640 x 480 pixels. Pediatric retinal photograph (wide-field). 130° field of view (Clarity RetCam 3).
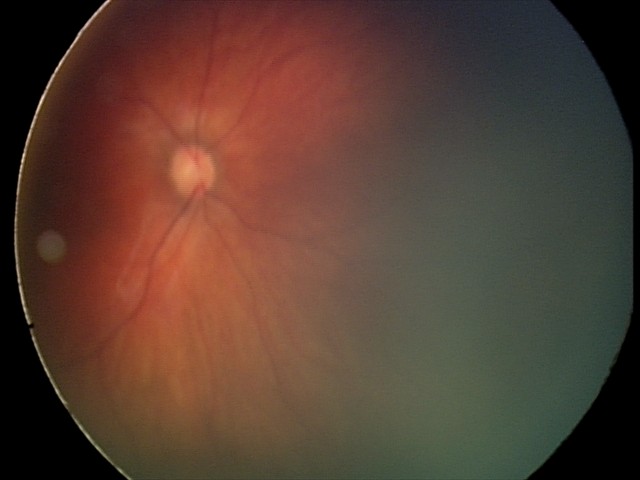
From an examination with diagnosis of retinal hemorrhages.